Modified Davis grading; camera: NIDEK AFC-230: 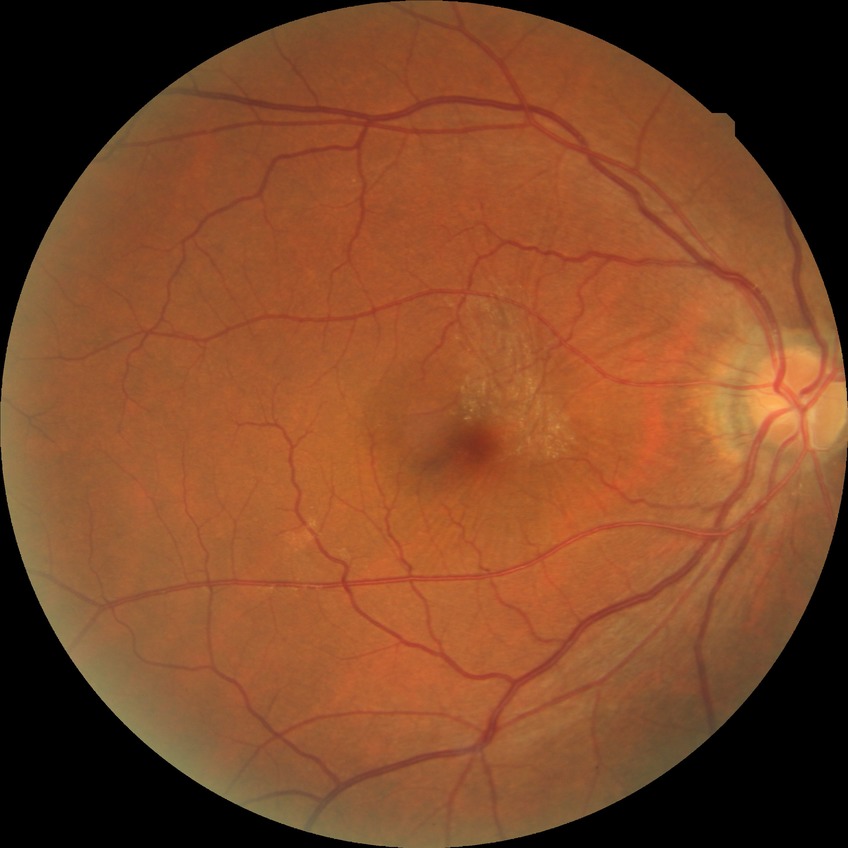

diabetic retinopathy (DR) = no diabetic retinopathy (NDR).